Portable fundus camera image
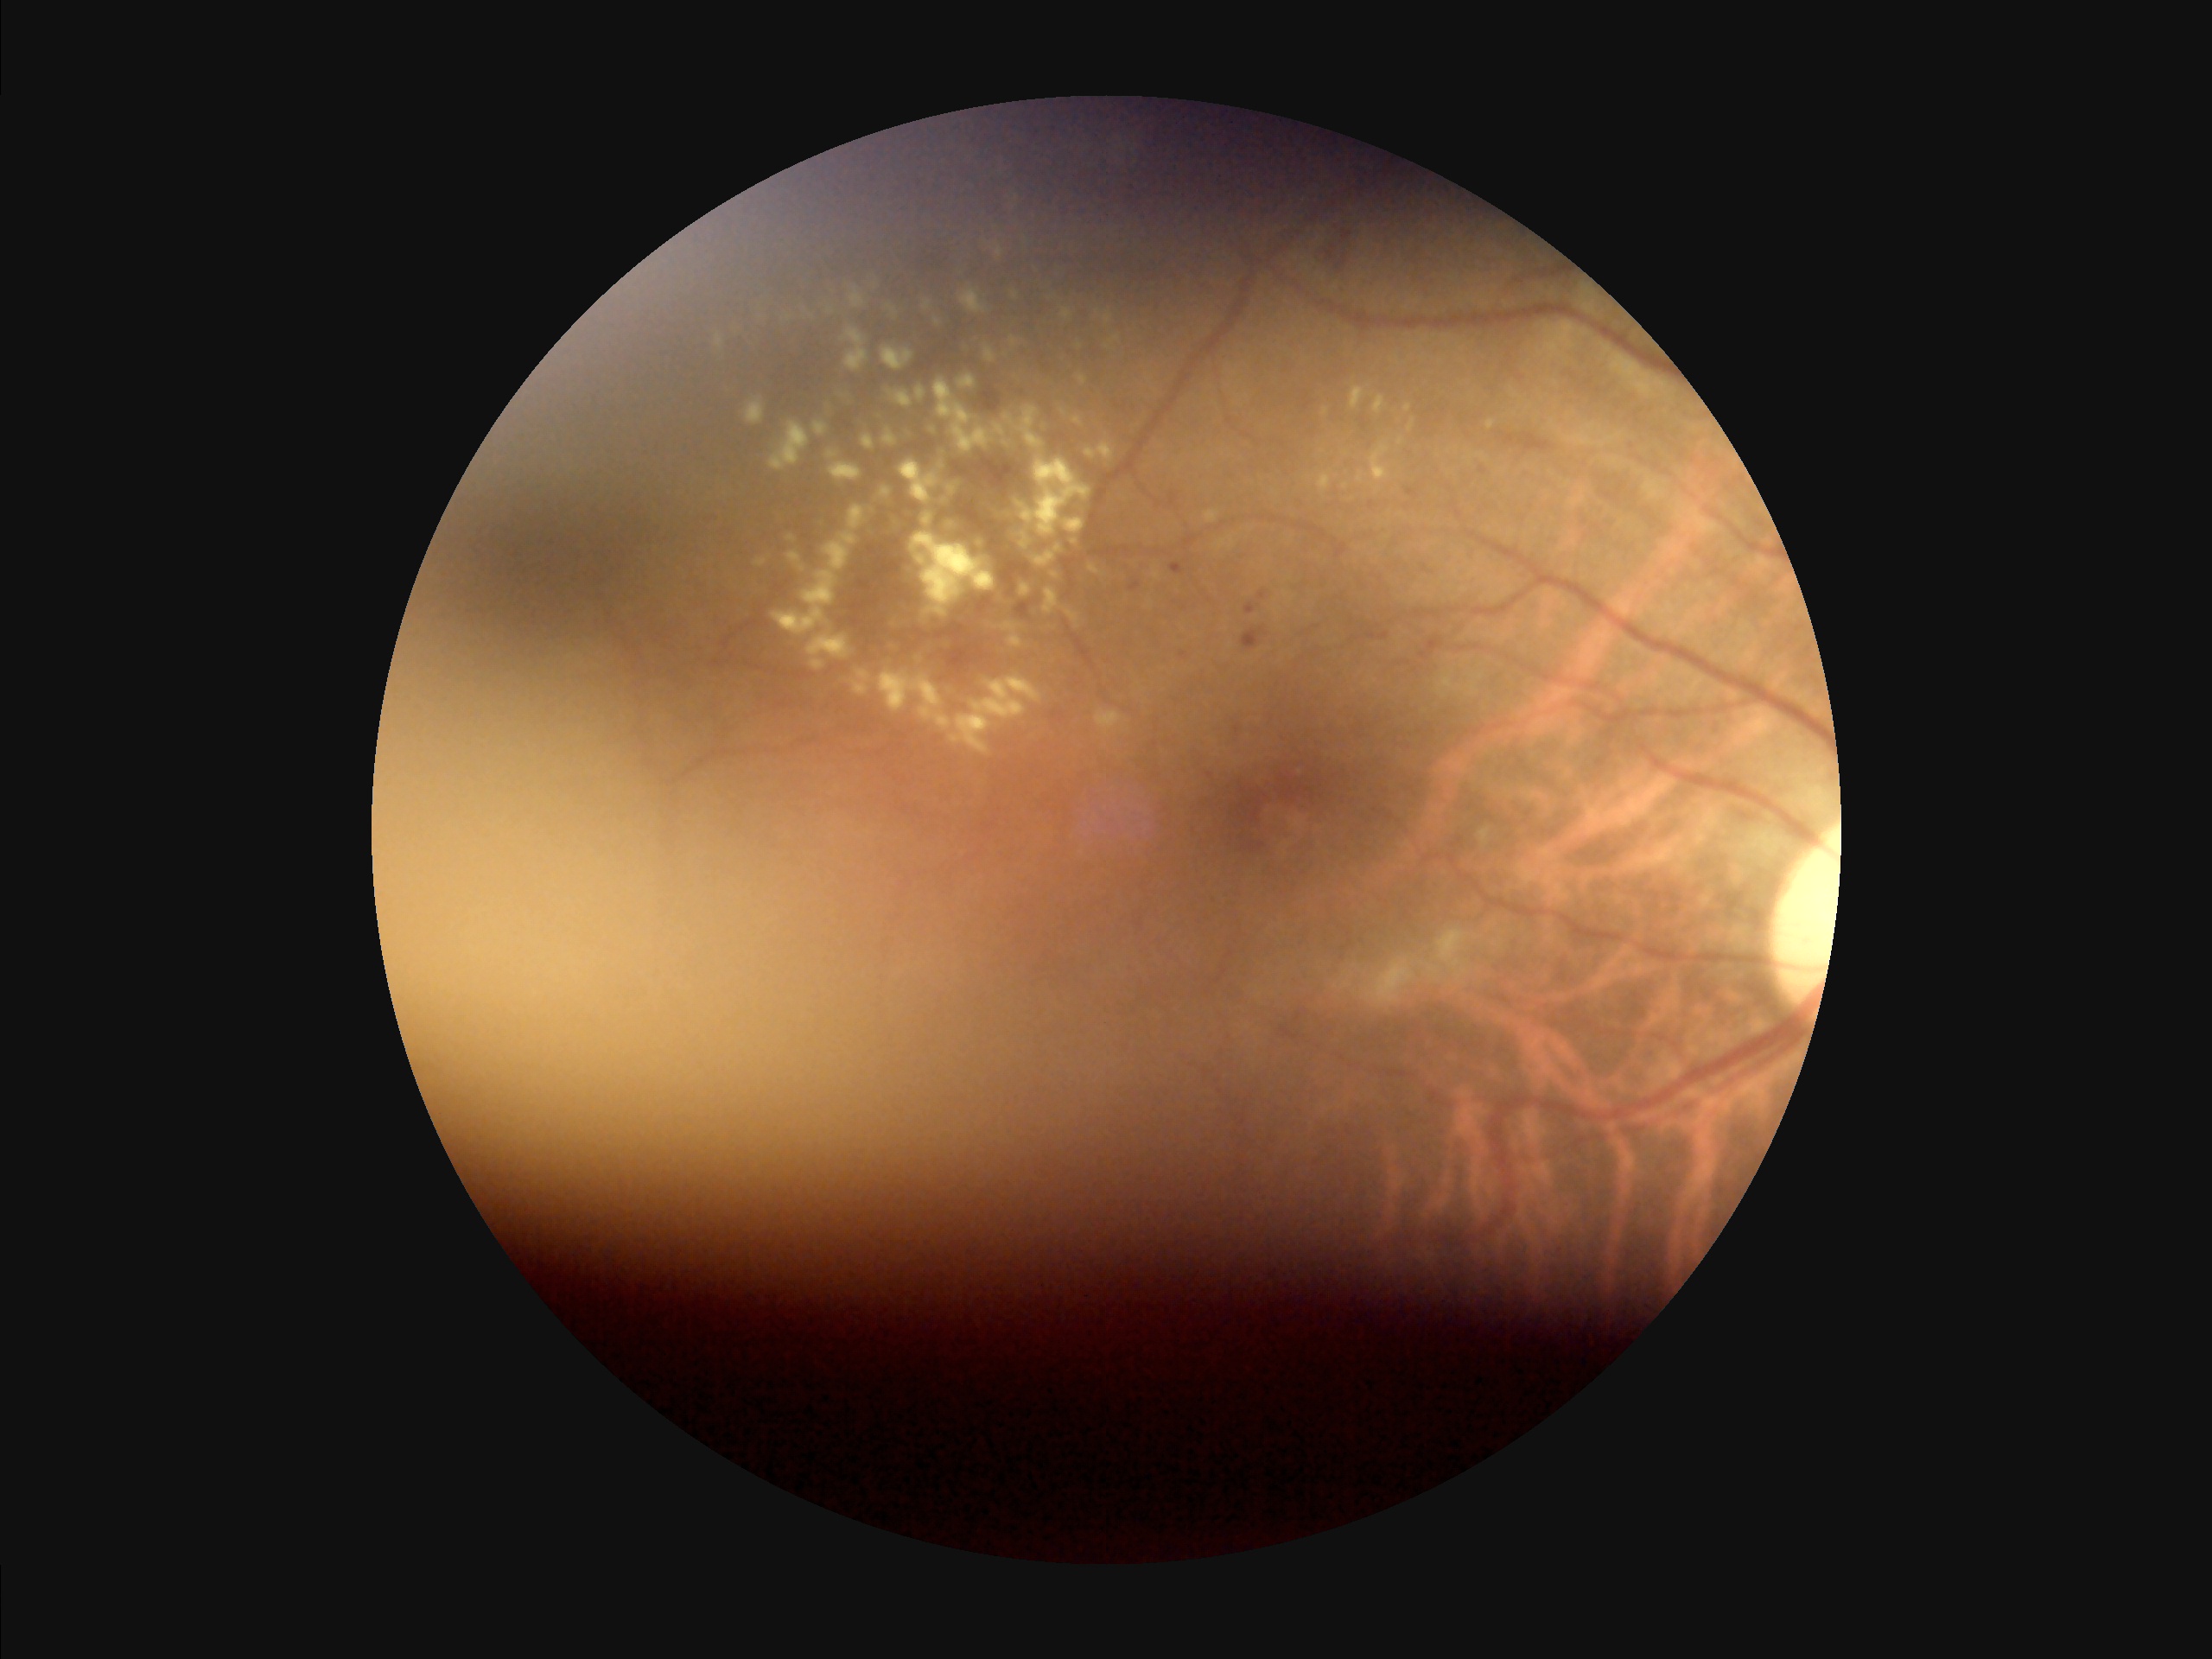

The image is blurry. Image quality is inadequate for diagnostic use. Illumination is uneven. Poor dynamic range.